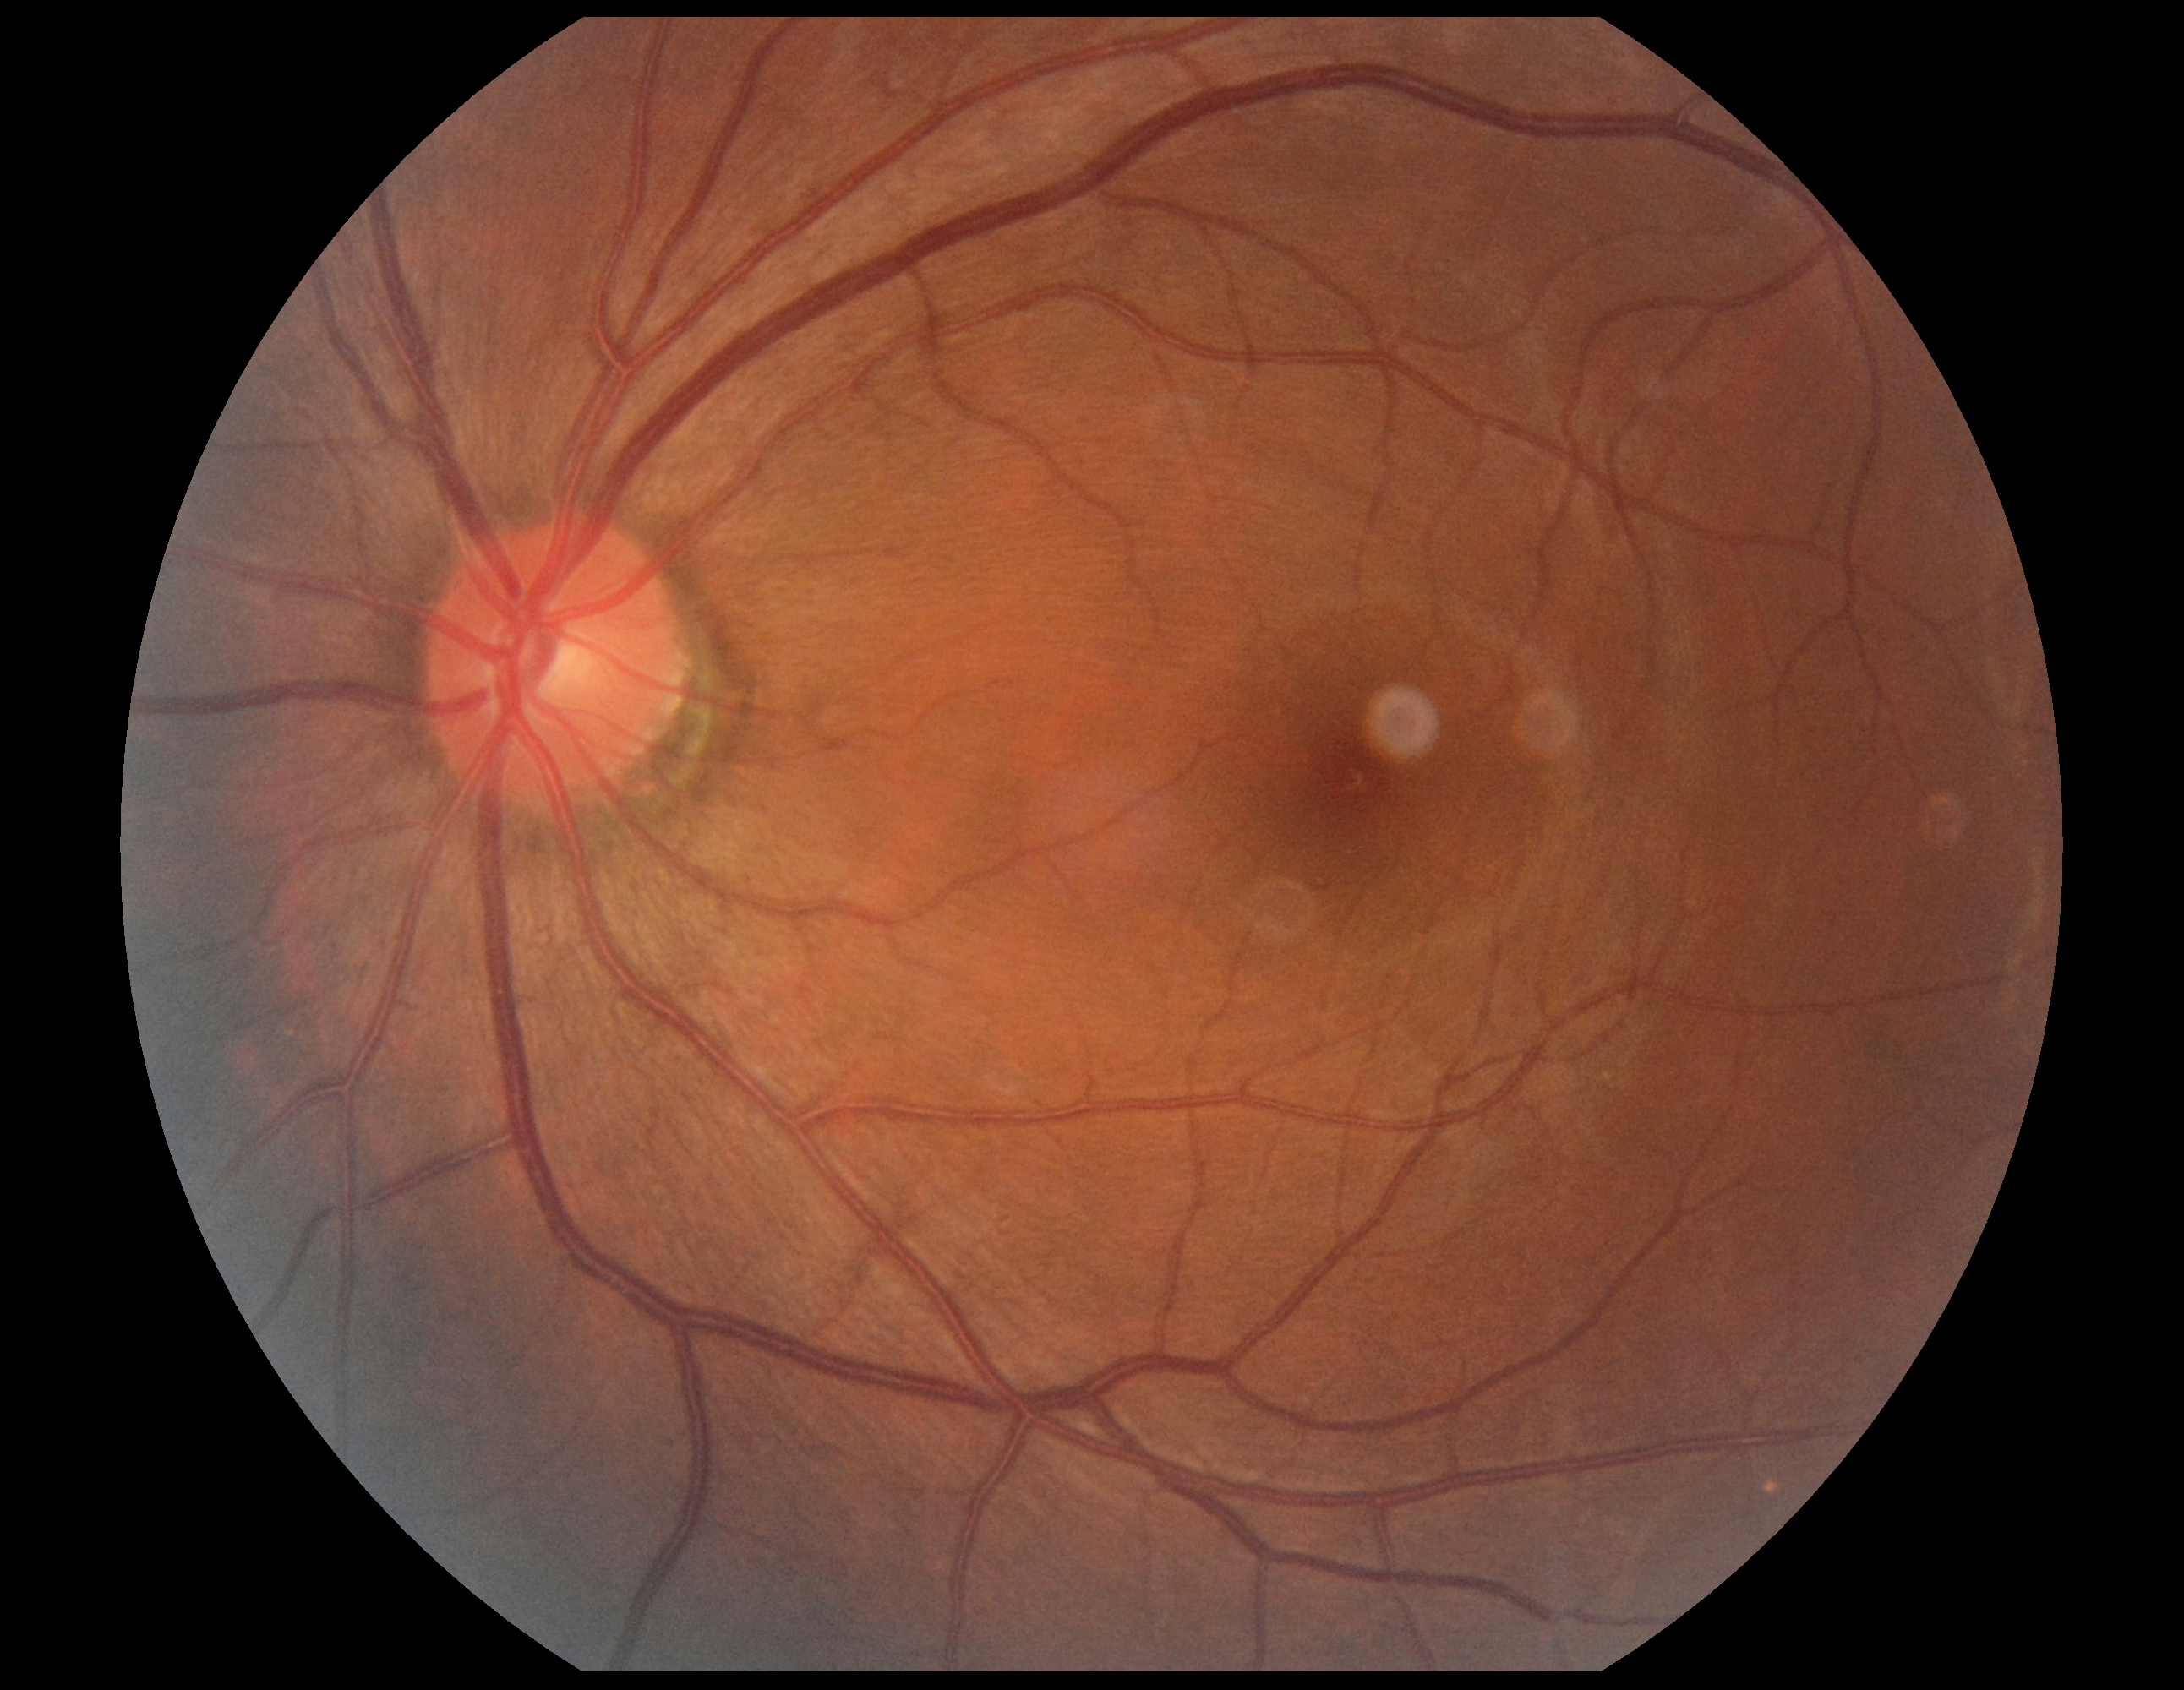

Diabetic retinopathy (DR) is grade 0 (no apparent retinopathy).